45° field of view — 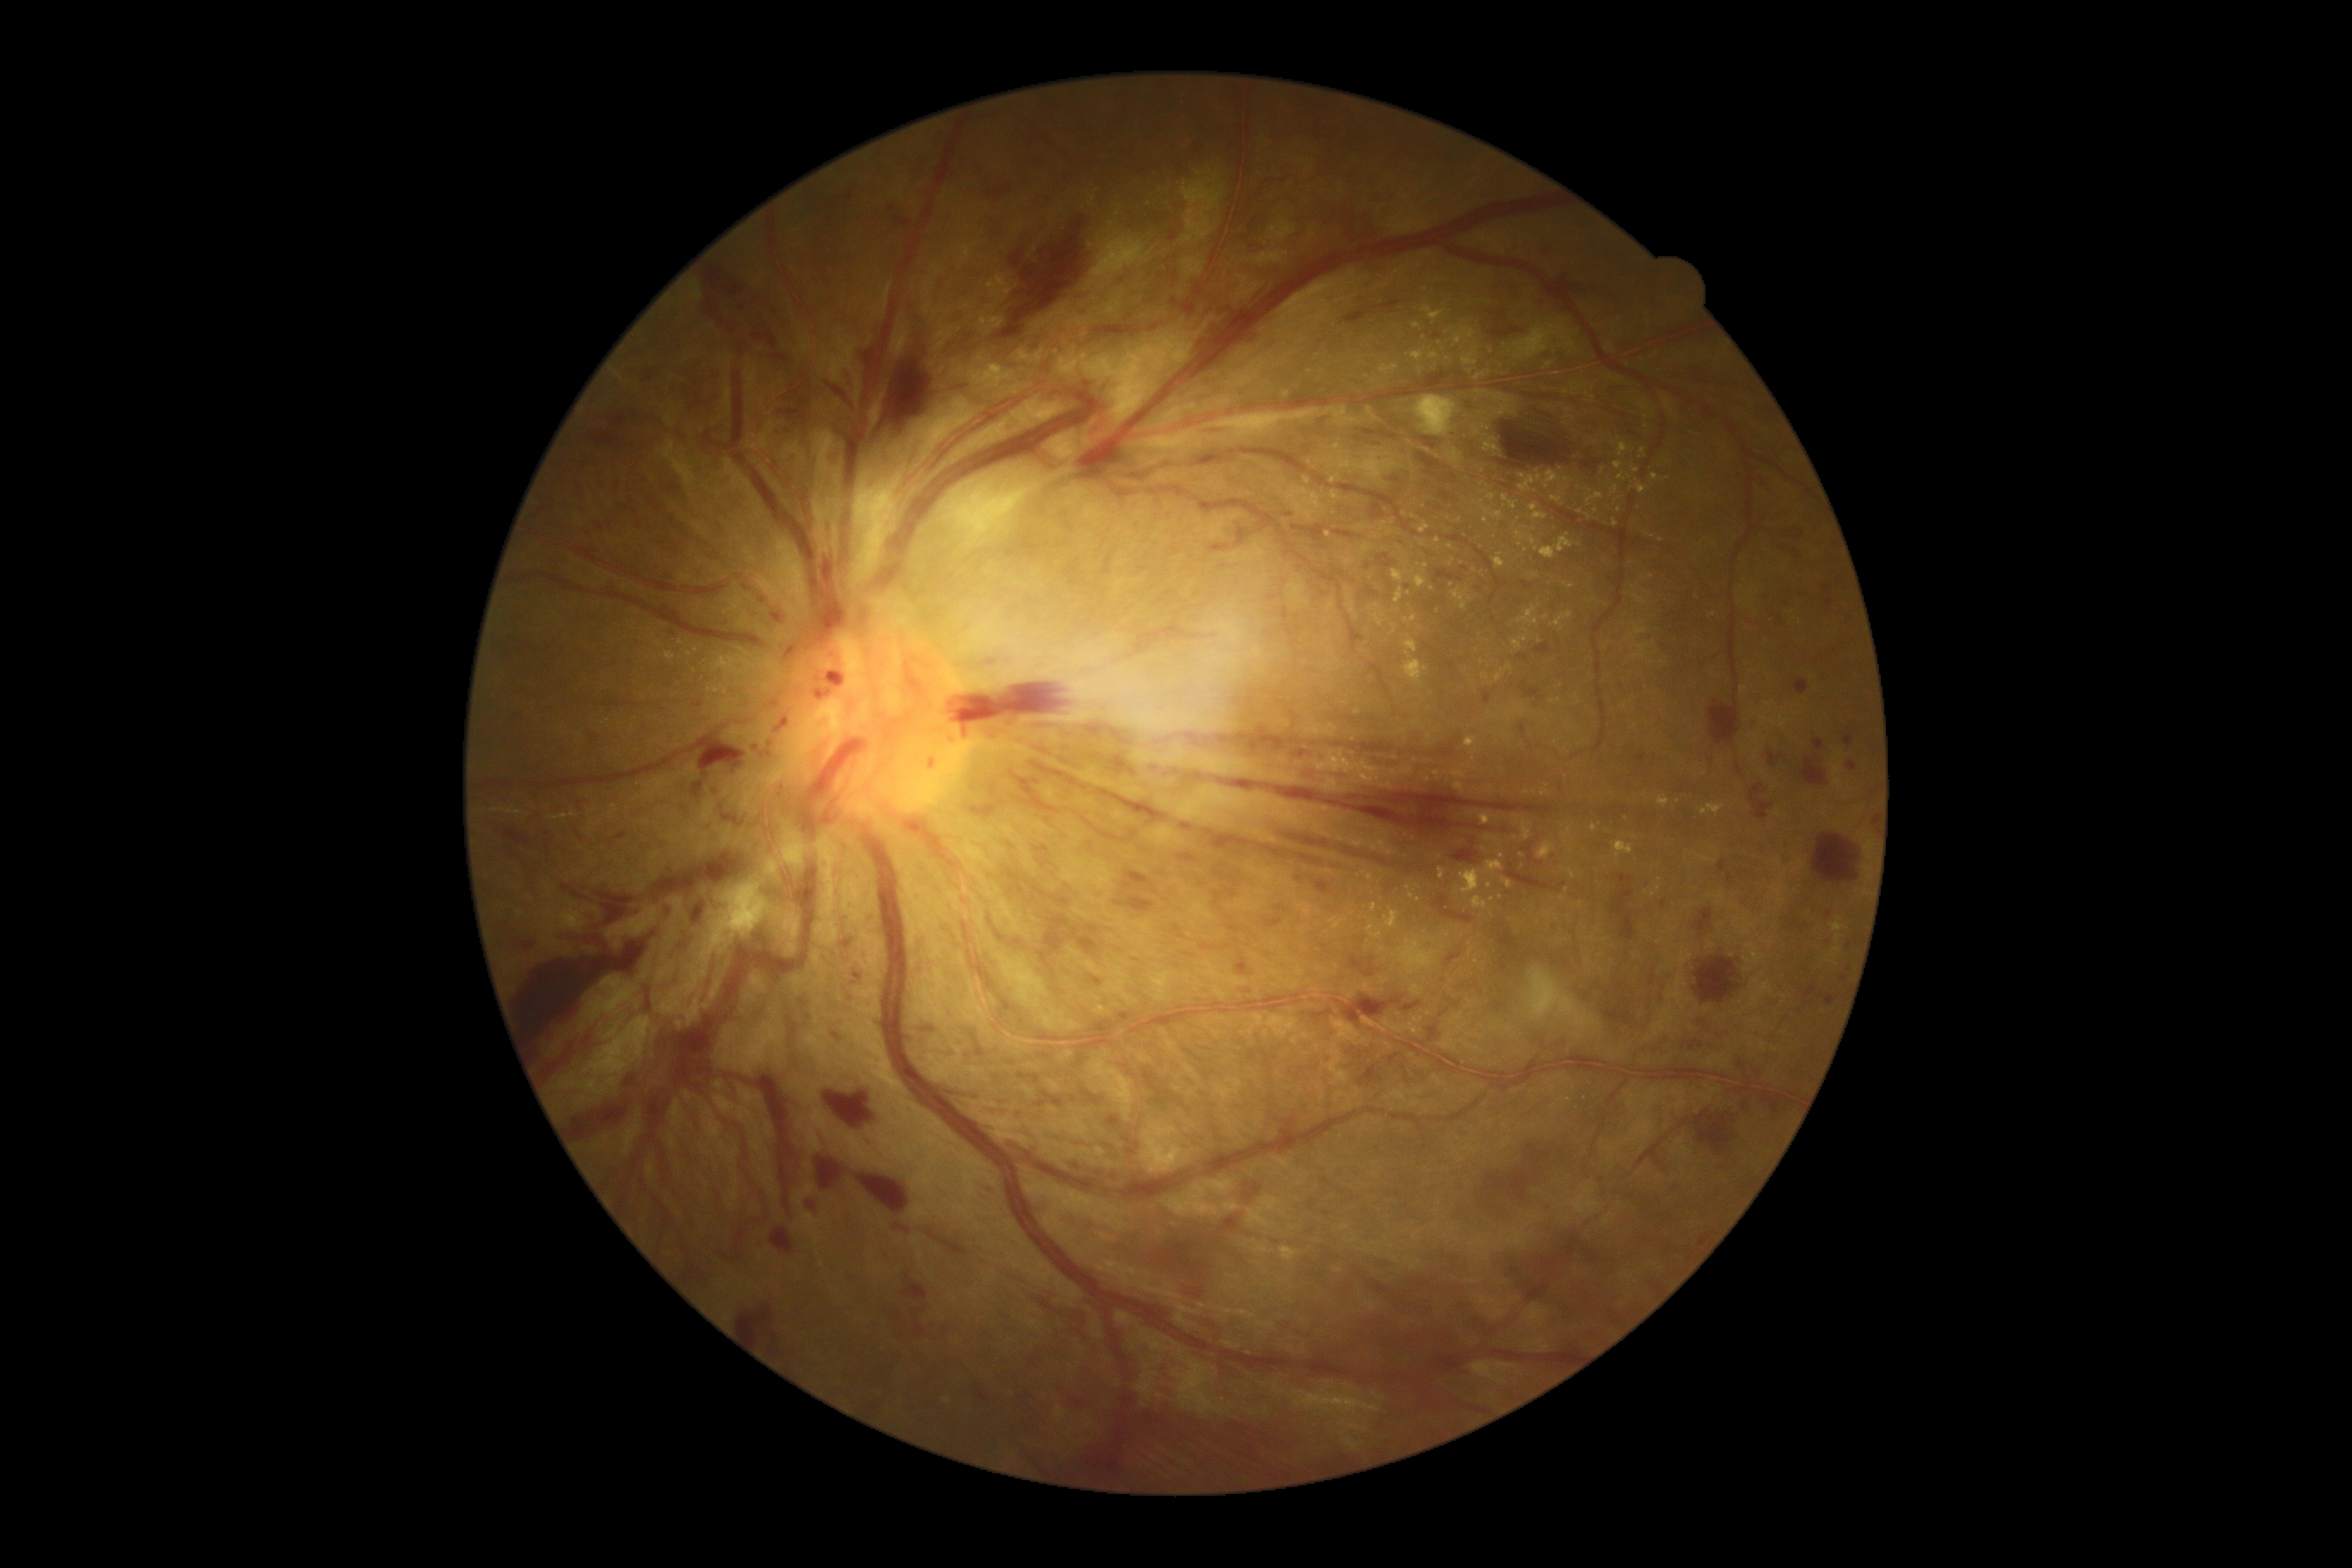
Retinopathy: proliferative diabetic retinopathy (grade 4); proliferative diabetic retinopathy
Selected lesions:
• hemorrhages (more not shown): rect(1519, 723, 1526, 737), rect(828, 515, 836, 542), rect(1610, 876, 1634, 916), rect(1691, 1017, 1712, 1032), rect(577, 797, 592, 804), rect(824, 1091, 873, 1127), rect(1125, 1351, 1142, 1381), rect(859, 341, 867, 364), rect(995, 929, 1005, 943), rect(1657, 1151, 1672, 1177), rect(1057, 1302, 1087, 1325), rect(1813, 833, 1859, 885), rect(520, 943, 536, 948), rect(778, 407, 804, 417), rect(1528, 1142, 1538, 1160), rect(1074, 312, 1087, 315), rect(1034, 1075, 1041, 1084), rect(1318, 1275, 1491, 1371)
• Additional small hemorrhages near Point(769, 755), Point(1326, 1213)
• hard exudates (more not shown): rect(1330, 917, 1345, 929), rect(1614, 486, 1619, 496), rect(1404, 651, 1428, 685), rect(1502, 496, 1519, 510), rect(1363, 544, 1373, 553), rect(1366, 873, 1373, 881), rect(1614, 842, 1634, 859), rect(1564, 869, 1576, 879), rect(1479, 814, 1491, 826), rect(1005, 1392, 1015, 1399), rect(1545, 364, 1553, 369)
• Additional small hard exudates near Point(1329, 535), Point(1377, 607), Point(1428, 762), Point(1587, 395), Point(1223, 1400), Point(1526, 551), Point(1372, 528), Point(1643, 453), Point(1415, 517)